848 x 848 pixels · Davis DR grading: 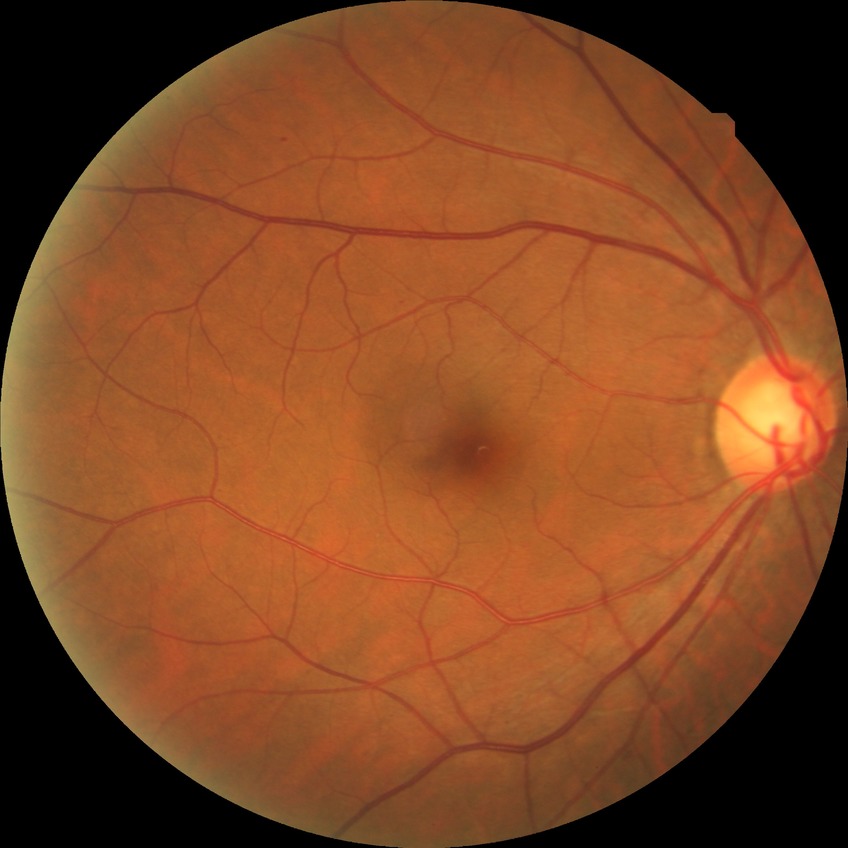
diabetic retinopathy (DR)@simple diabetic retinopathy (SDR).